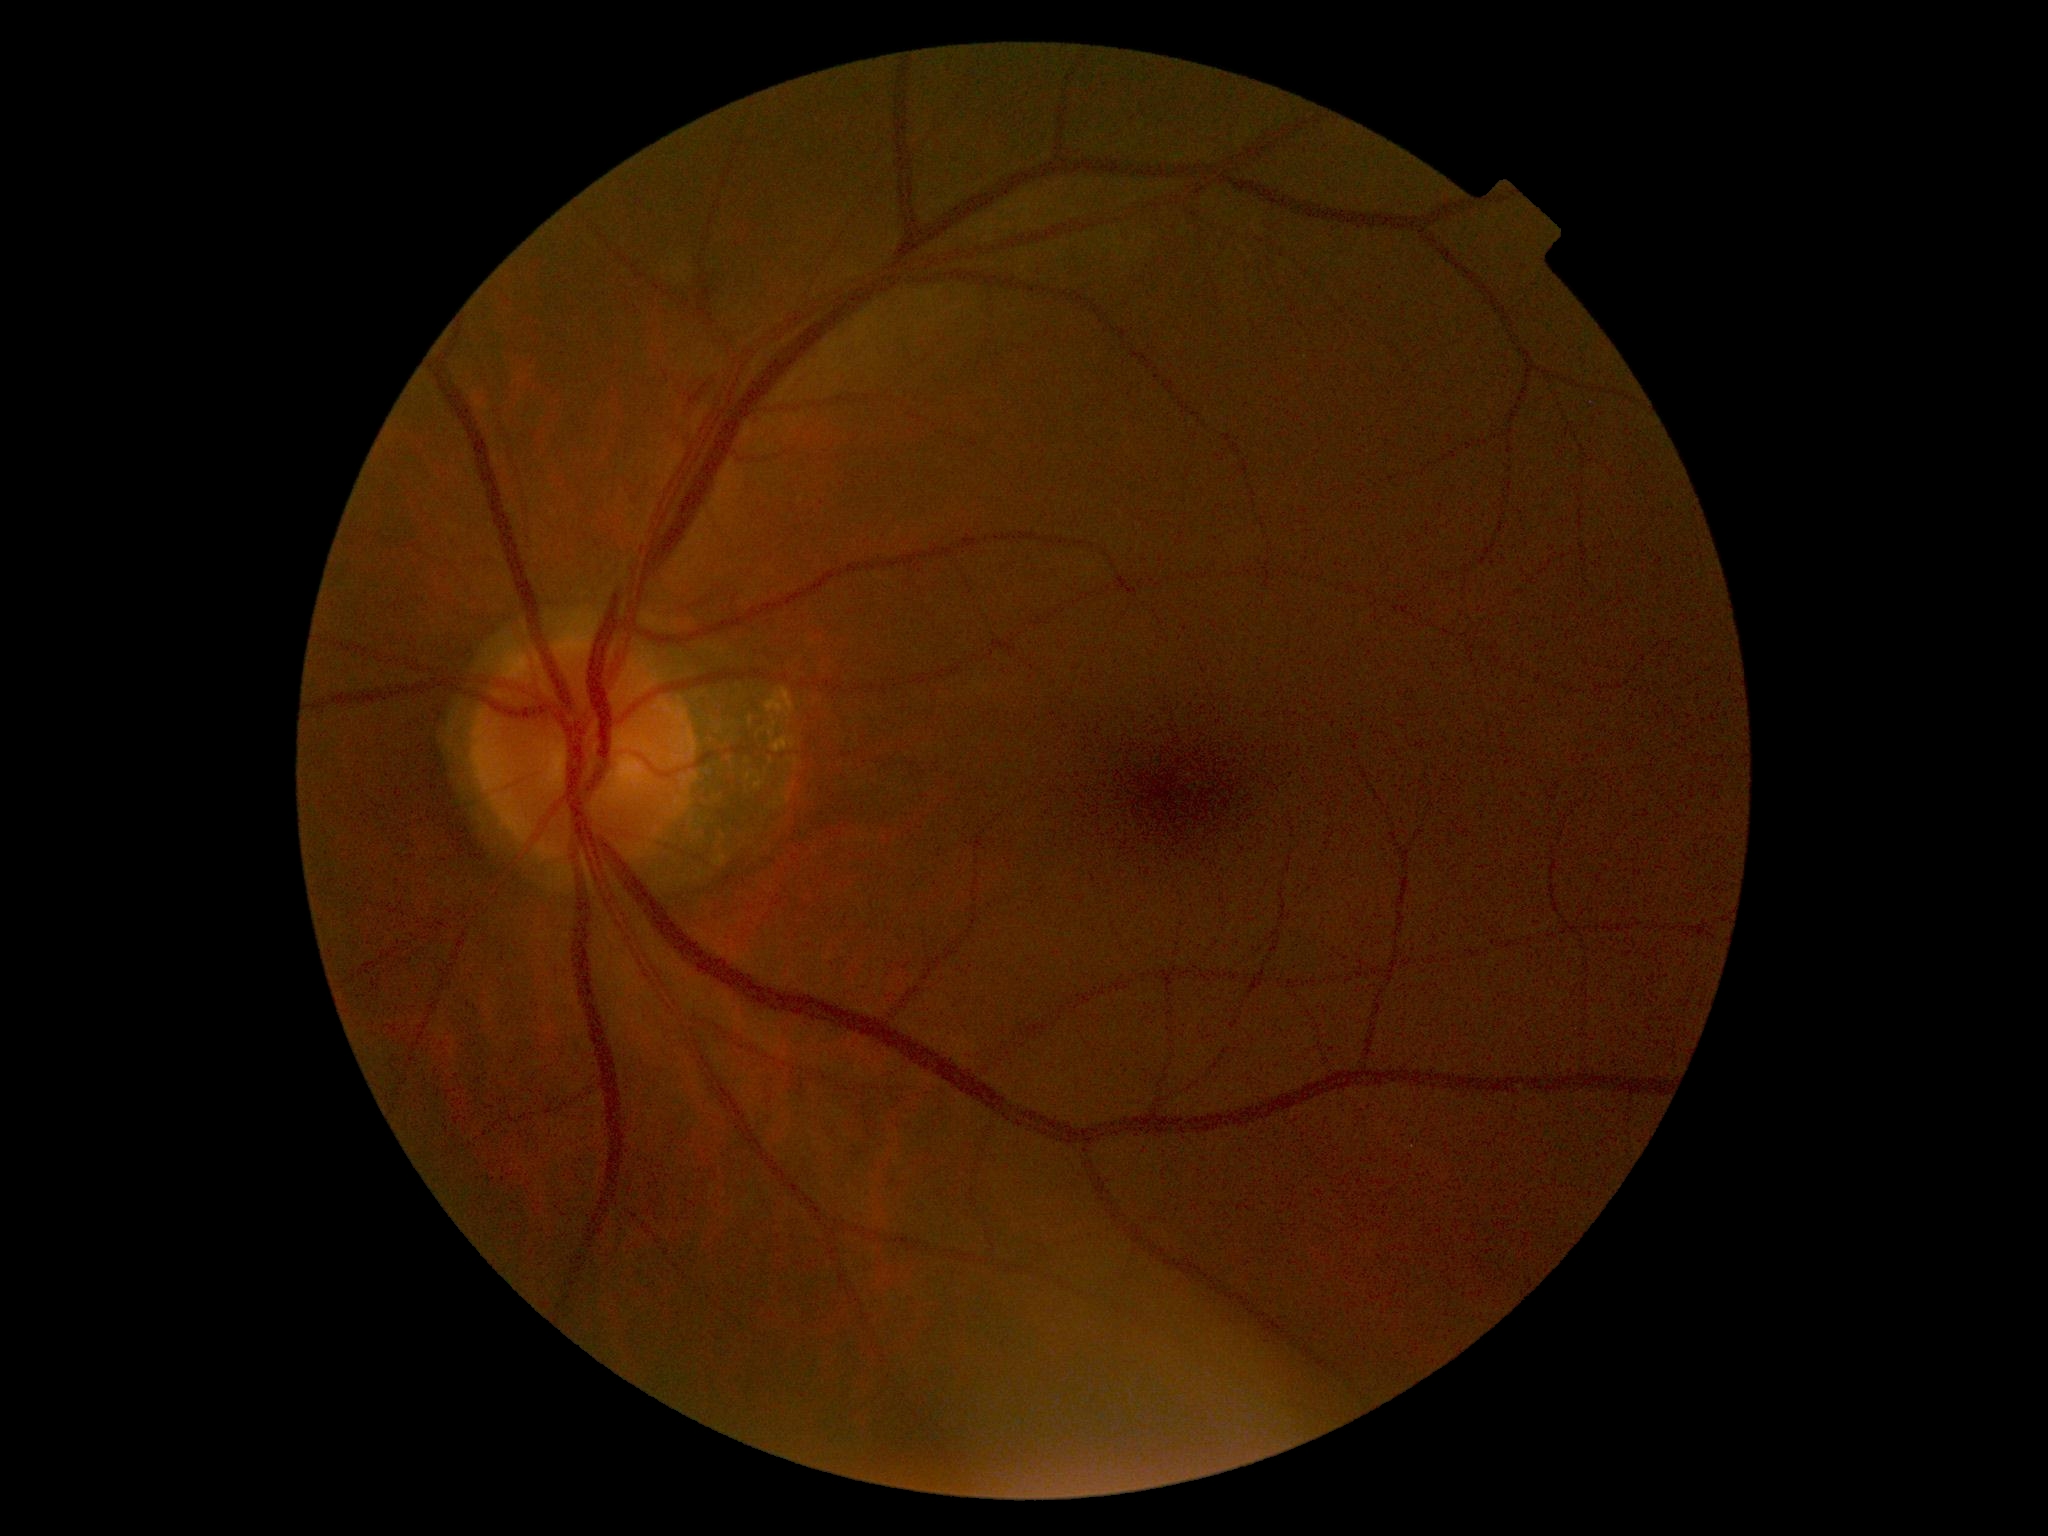 • diabetic retinopathy: 2
• DR class: non-proliferative diabetic retinopathy